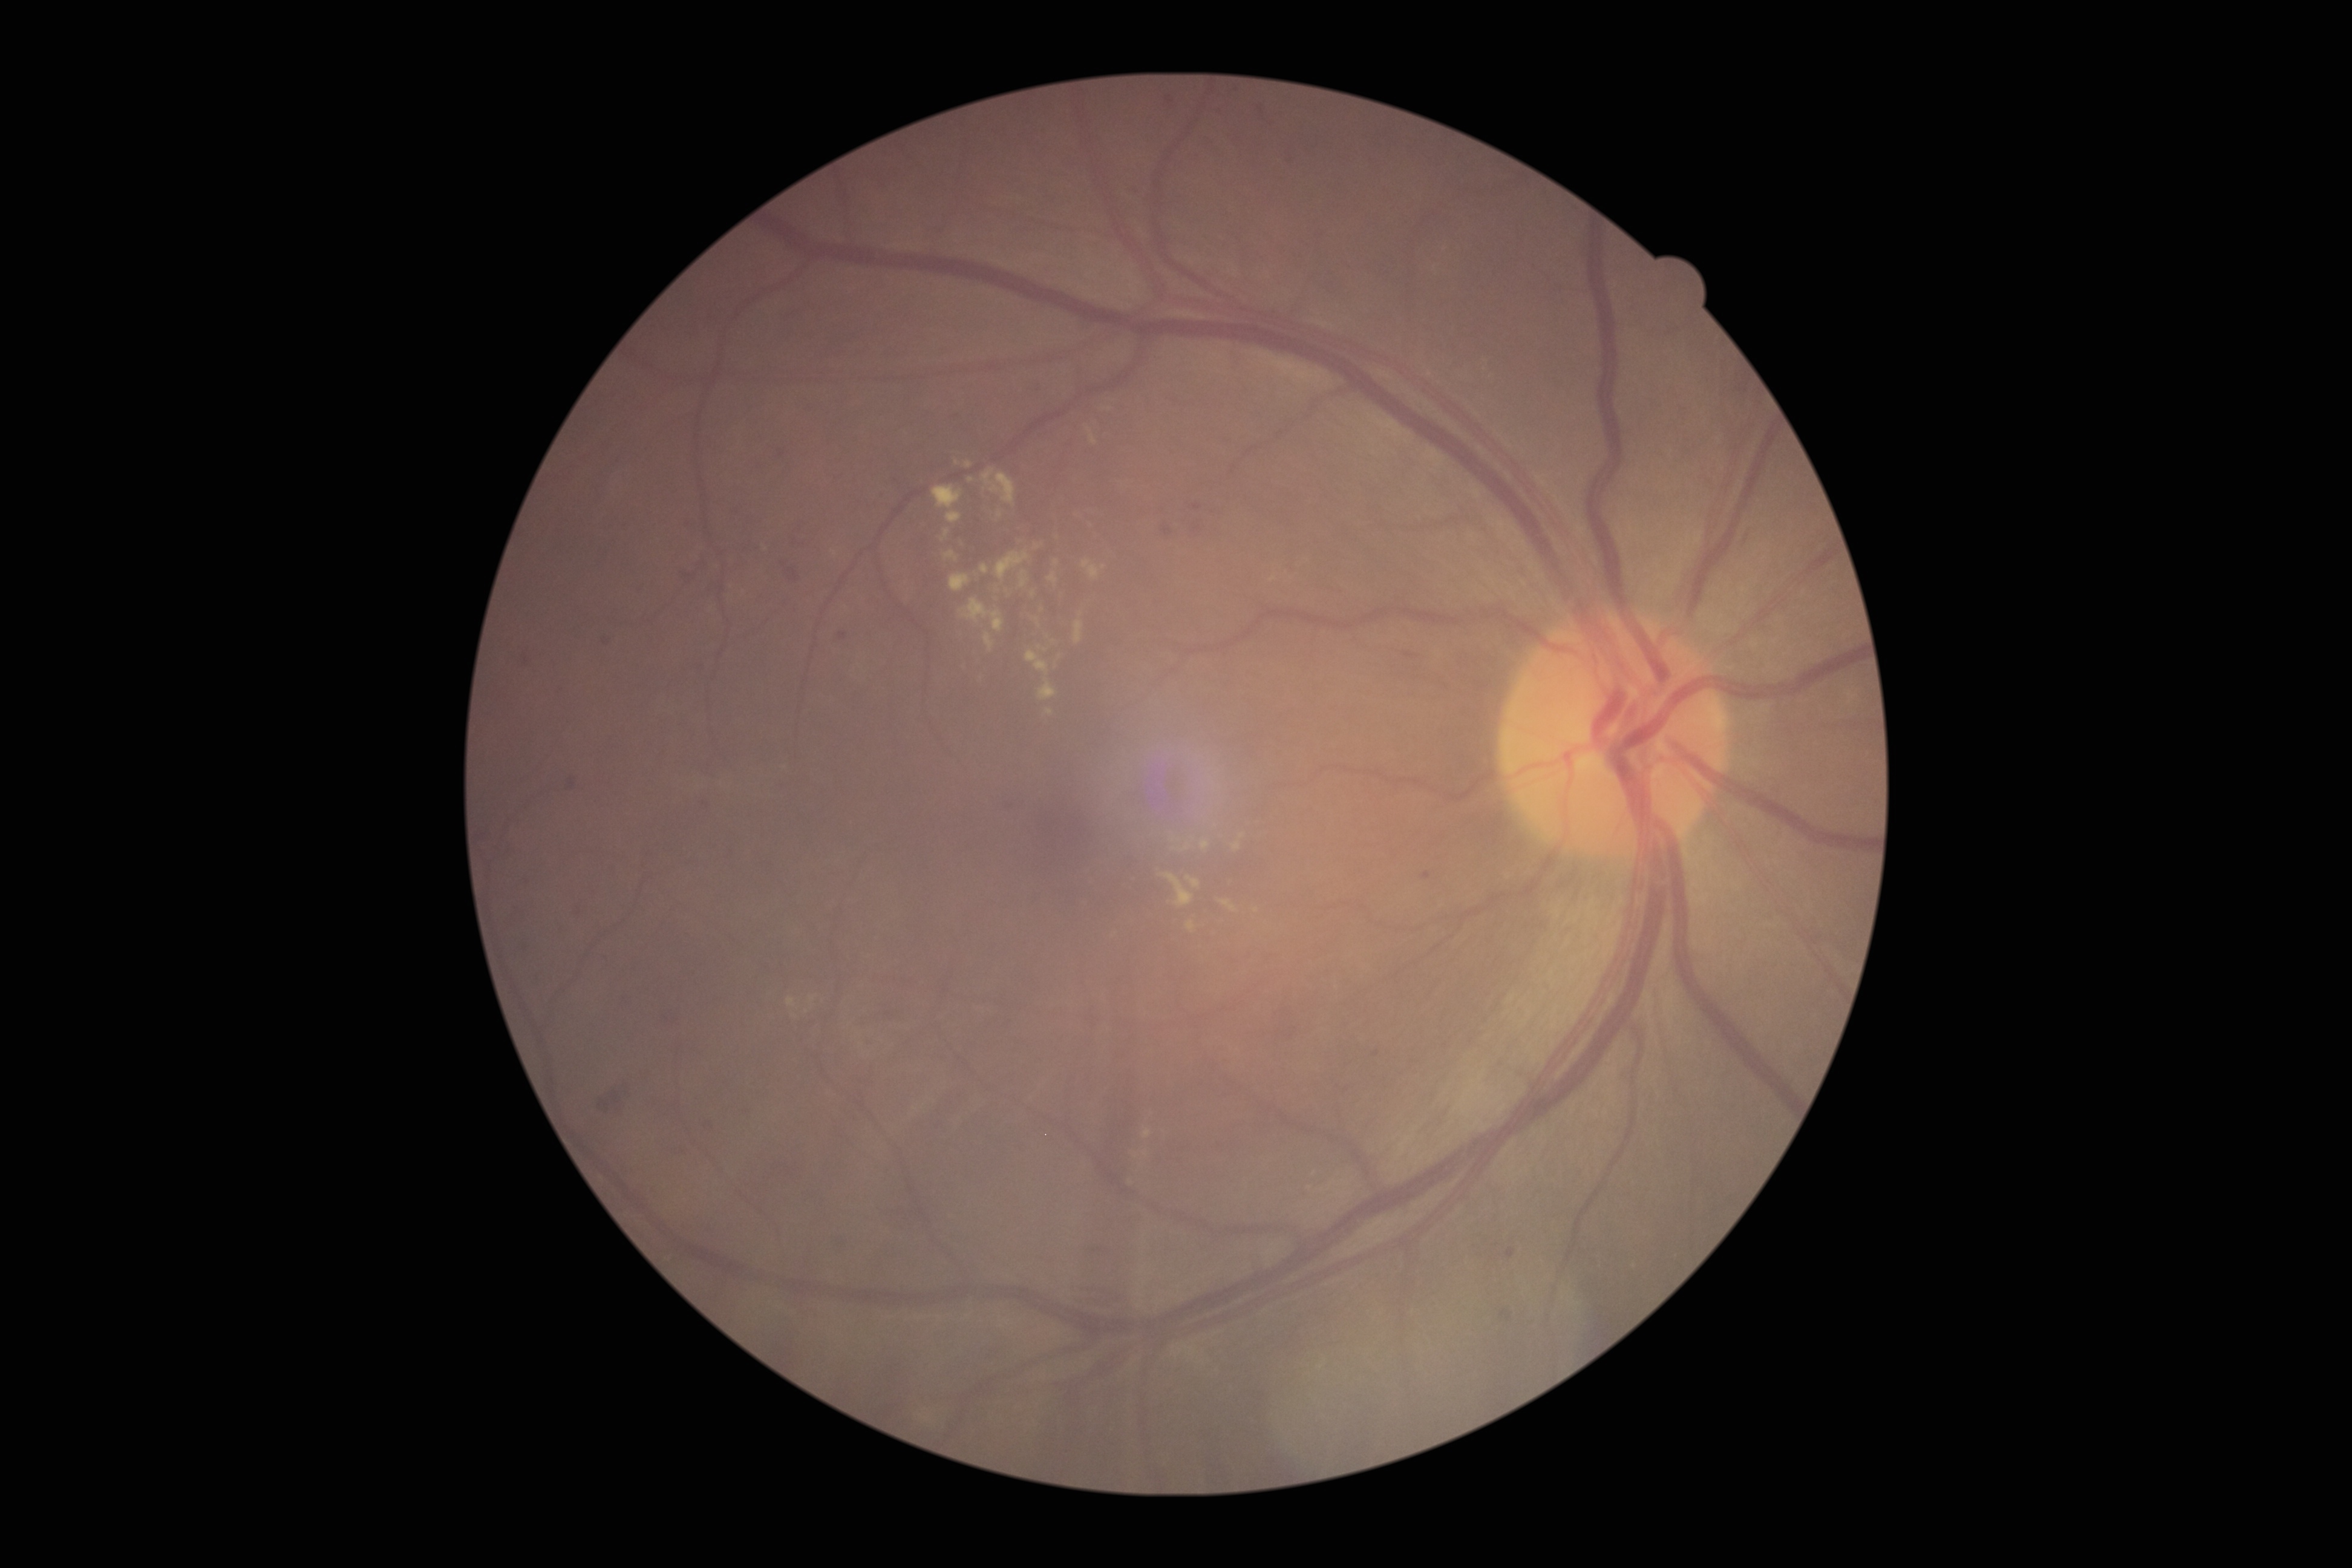

Diabetic retinopathy grade is 2
Representative lesions:
hard exudates (partial) = left=1021, top=572, right=1029, bottom=589; left=1082, top=561, right=1100, bottom=580; left=996, top=511, right=1002, bottom=520; left=947, top=512, right=962, bottom=524; left=1162, top=873, right=1195, bottom=908; left=965, top=462, right=973, bottom=469; left=1027, top=650, right=1048, bottom=676; left=1200, top=840, right=1209, bottom=851; left=1186, top=921, right=1196, bottom=933
Additional small hard exudates near Point(1104, 568); Point(1033, 594); Point(1061, 658); Point(1242, 837)